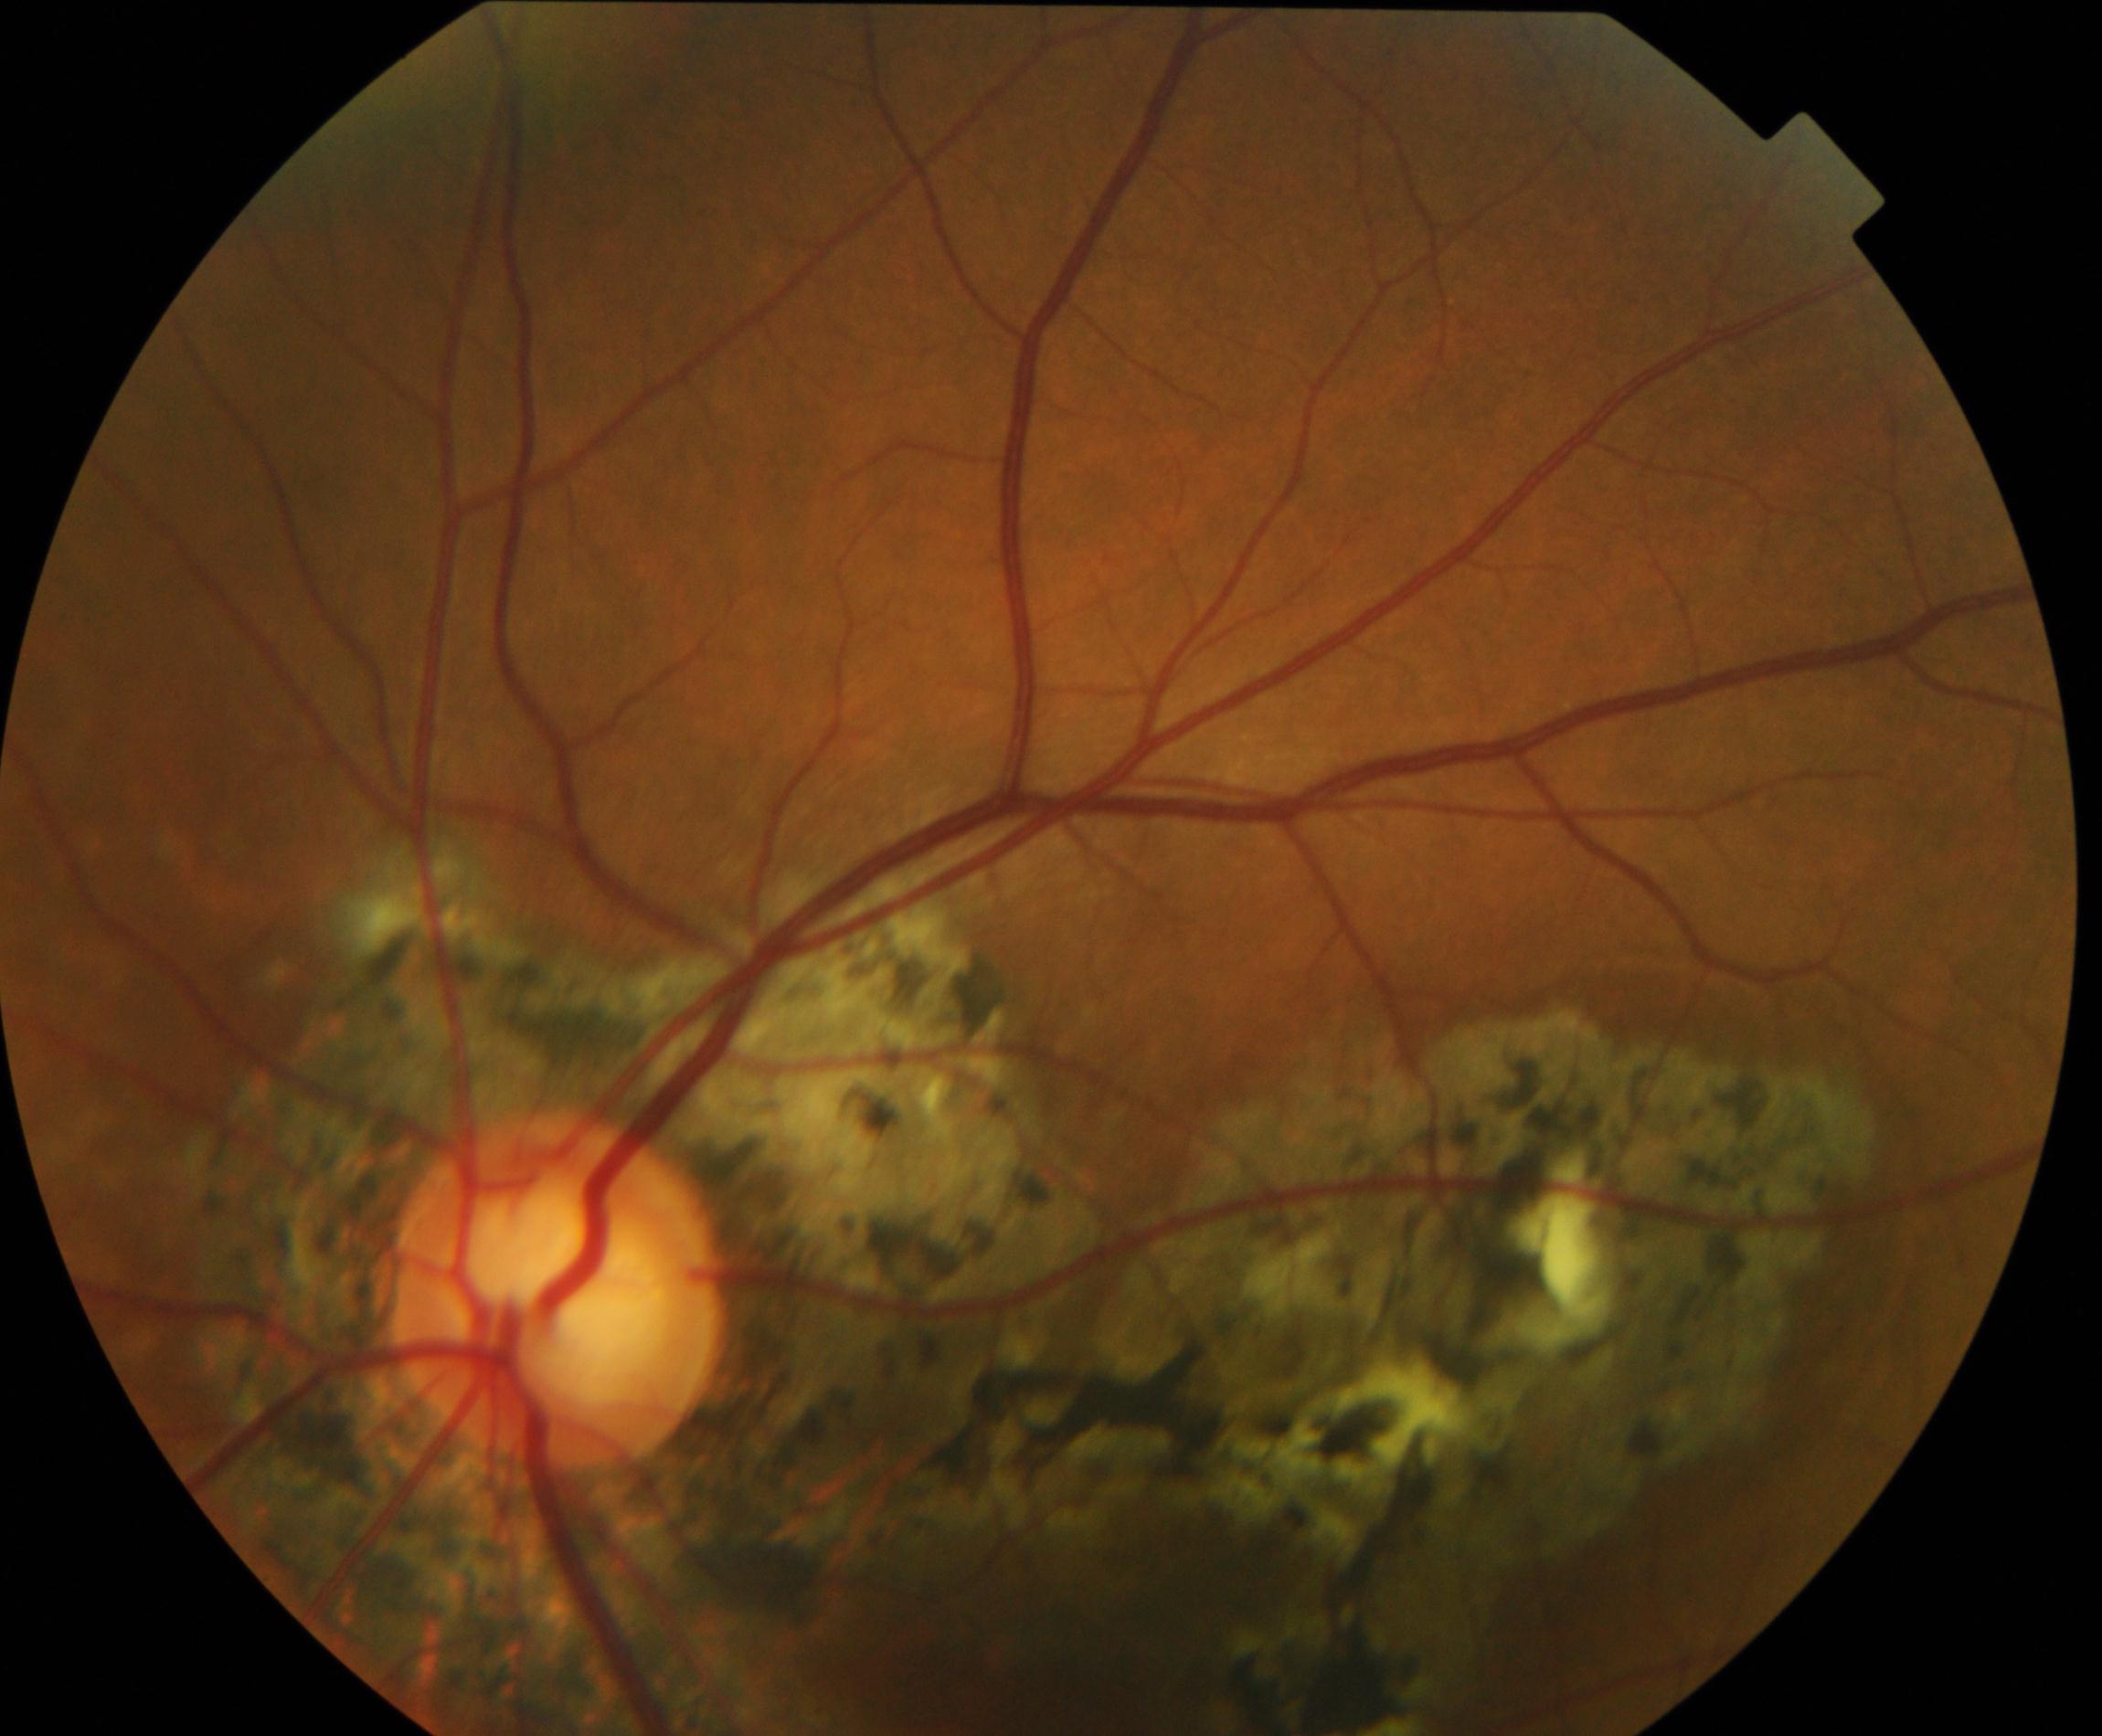

The image shows chorioretinal atrophy or coloboma. Features include focal or extensive retinal pigment epithelium and choroidal atrophy or coloboma.